Fundus photo.
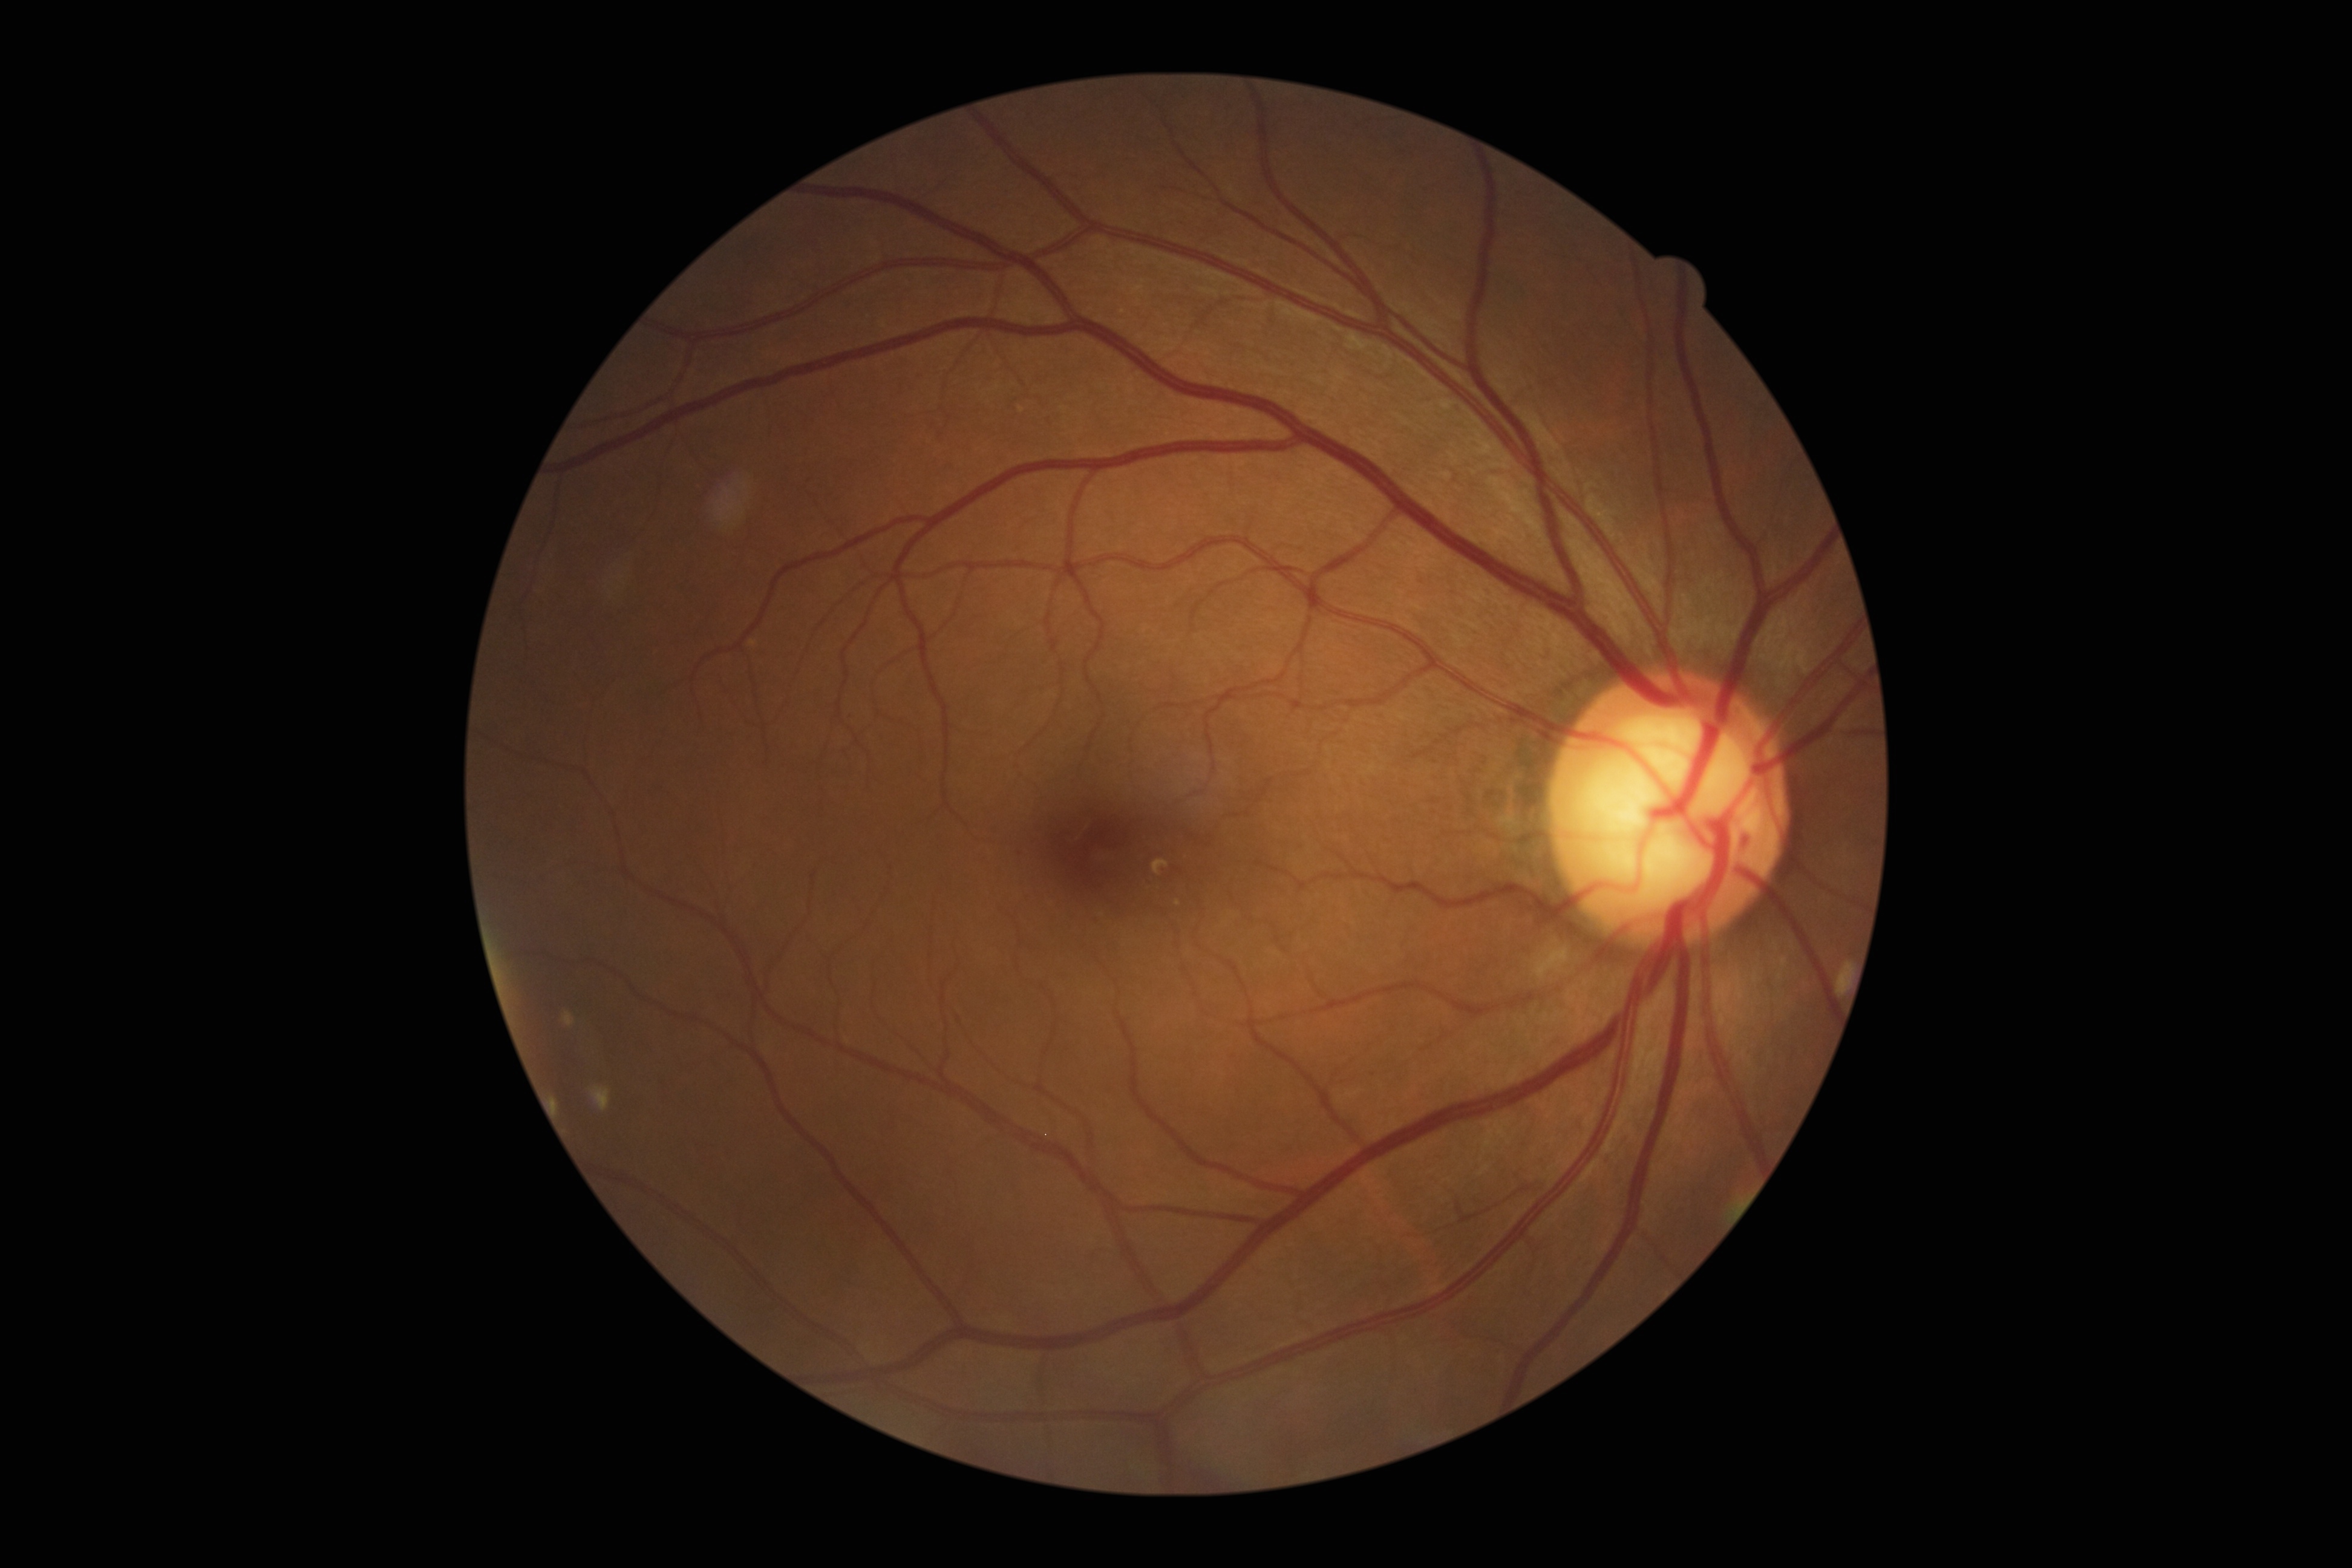
DR grade=2 (moderate NPDR).